Wide-field contact fundus photograph of an infant.
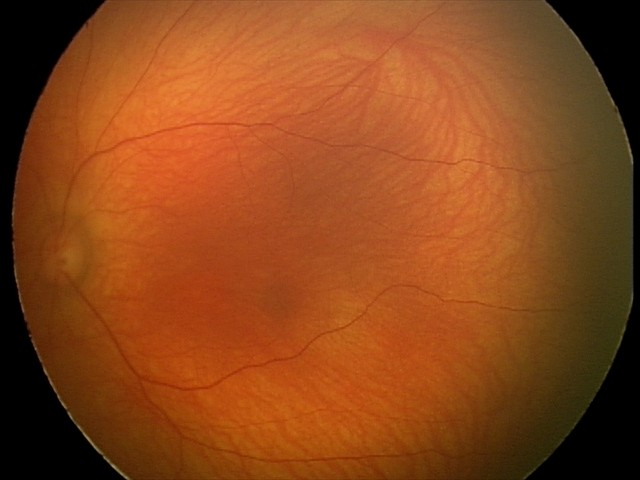

Screening examination with no abnormal retinal findings.